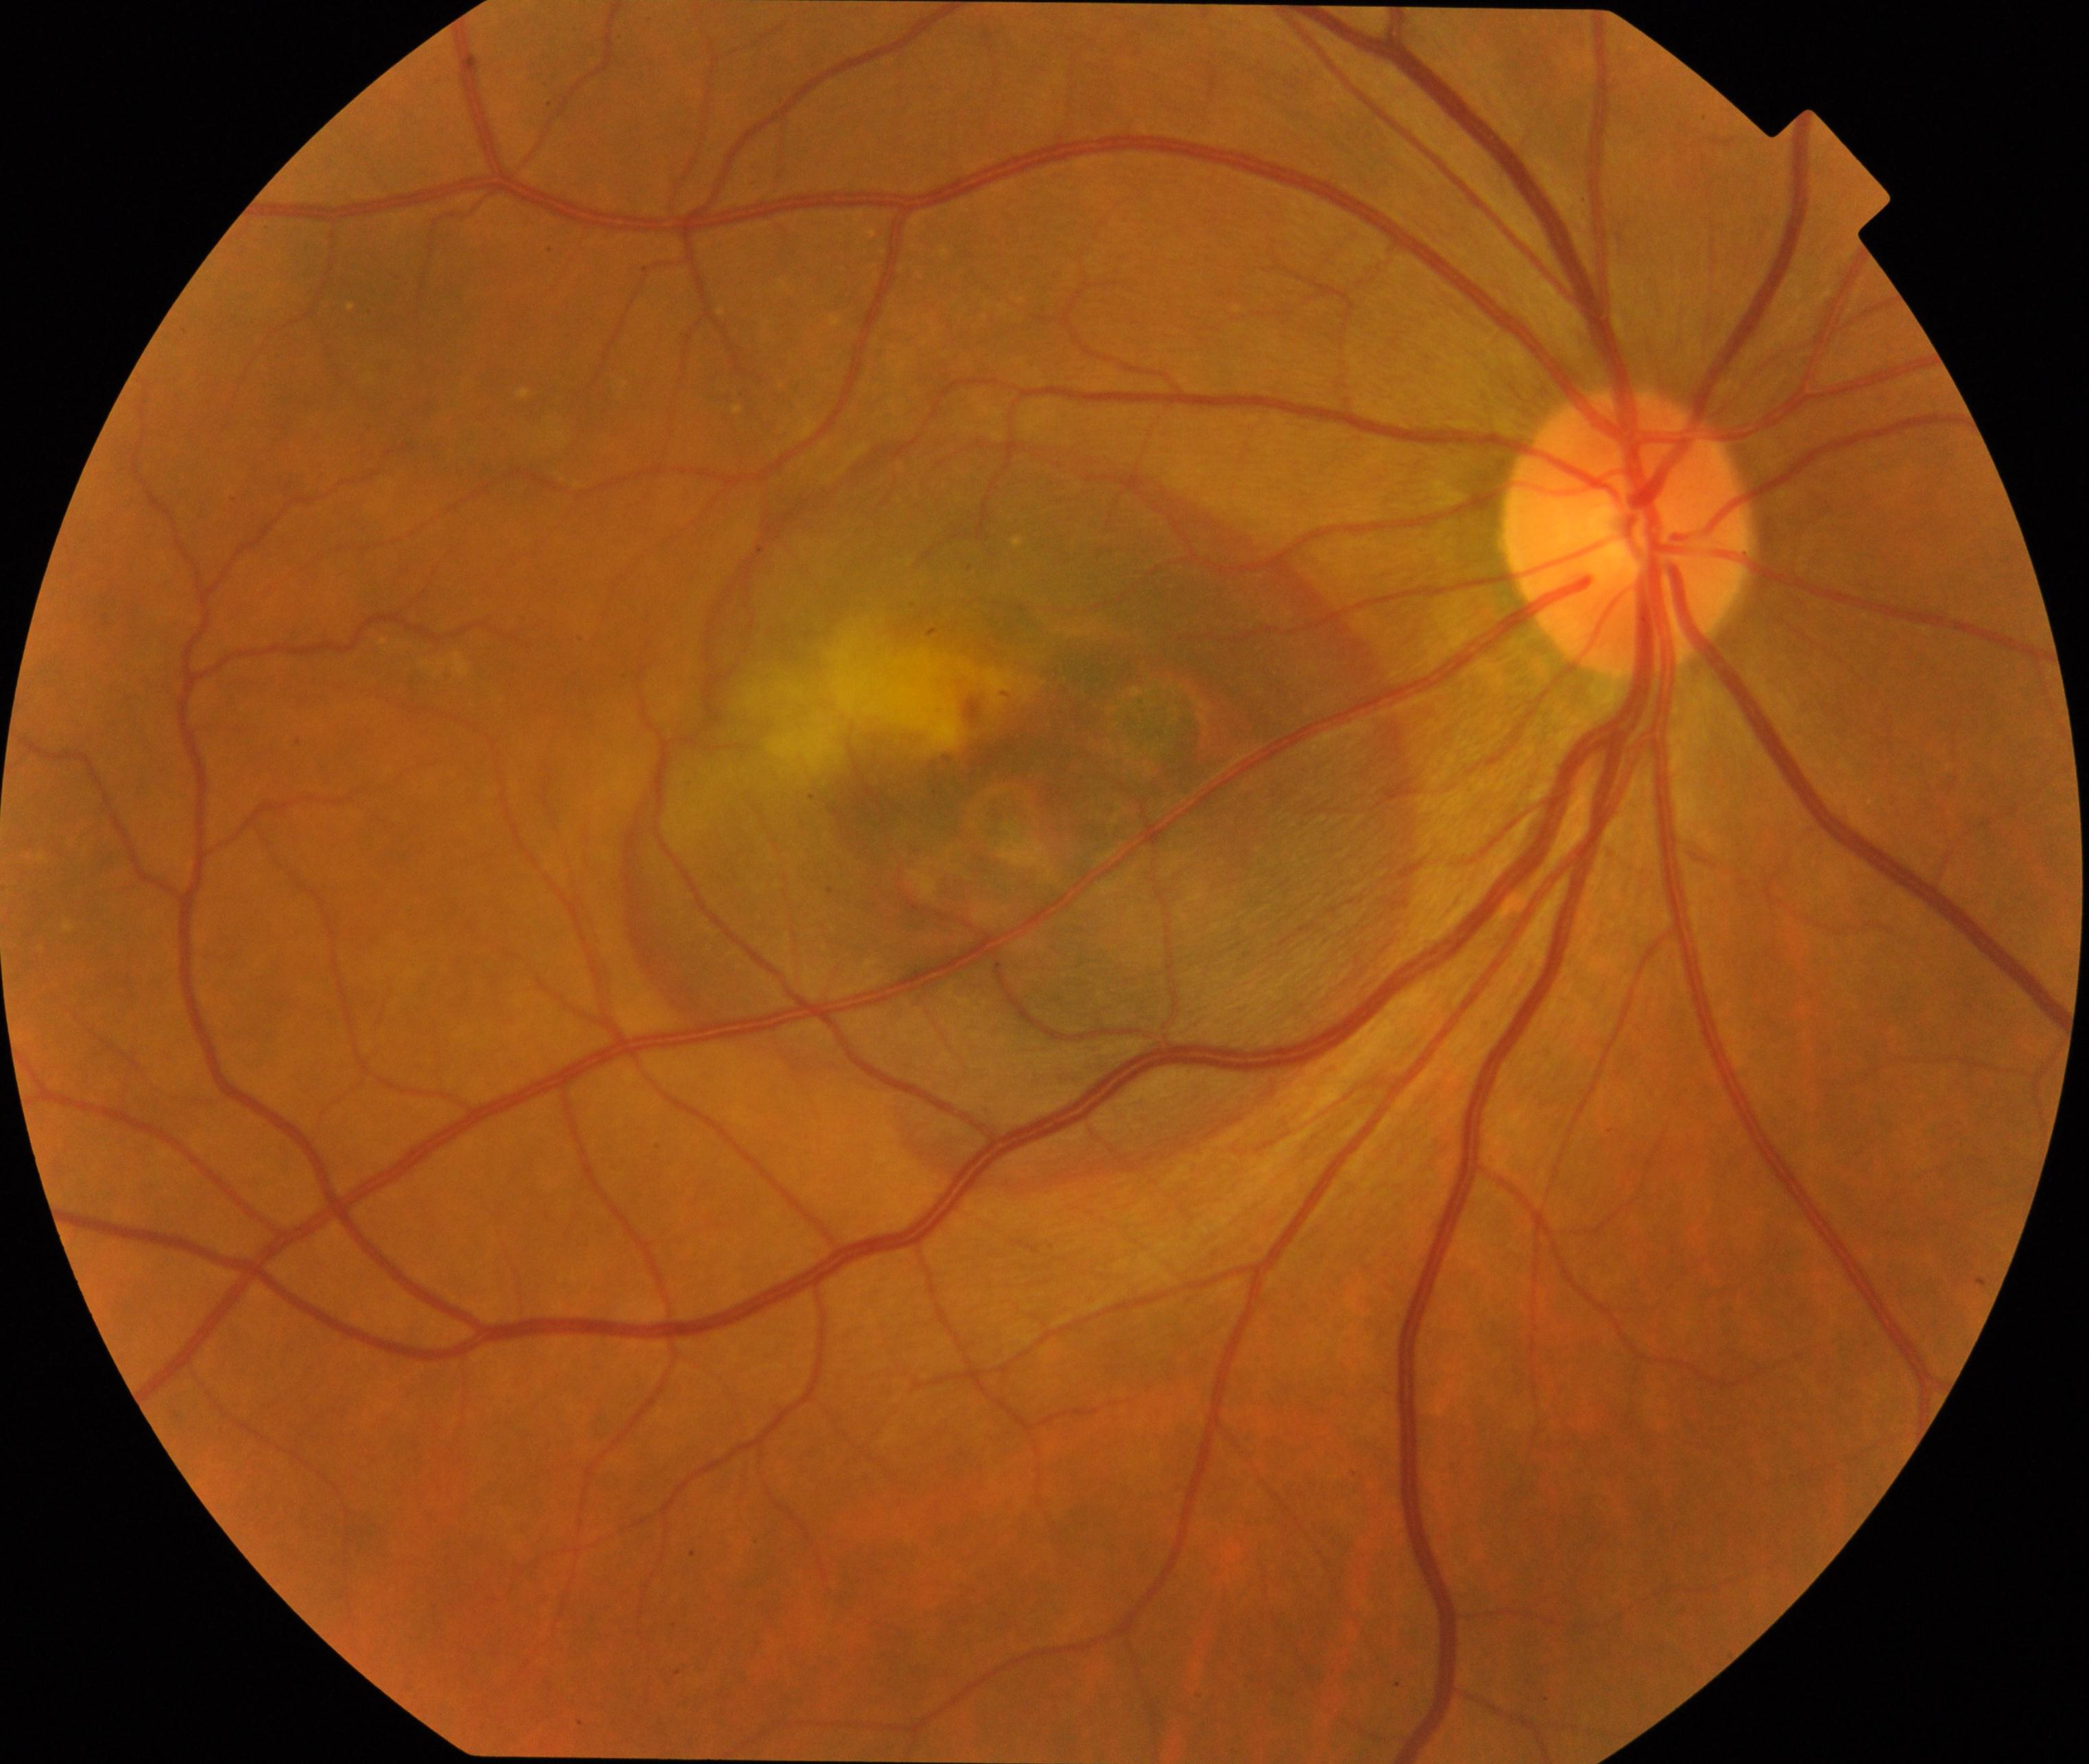
Classification: maculopathy. Defined by lesions within the macular area, such as intermediate or neovascular age-related macular degeneration, retinal angiomatous proliferation, polypoidal choroidal vasculopathy, choroidal neovascularization, idiopathic macular telangiectasia, and macular atrophy, not caused by other listed disease categories.